2089 by 1764 pixels · CFP
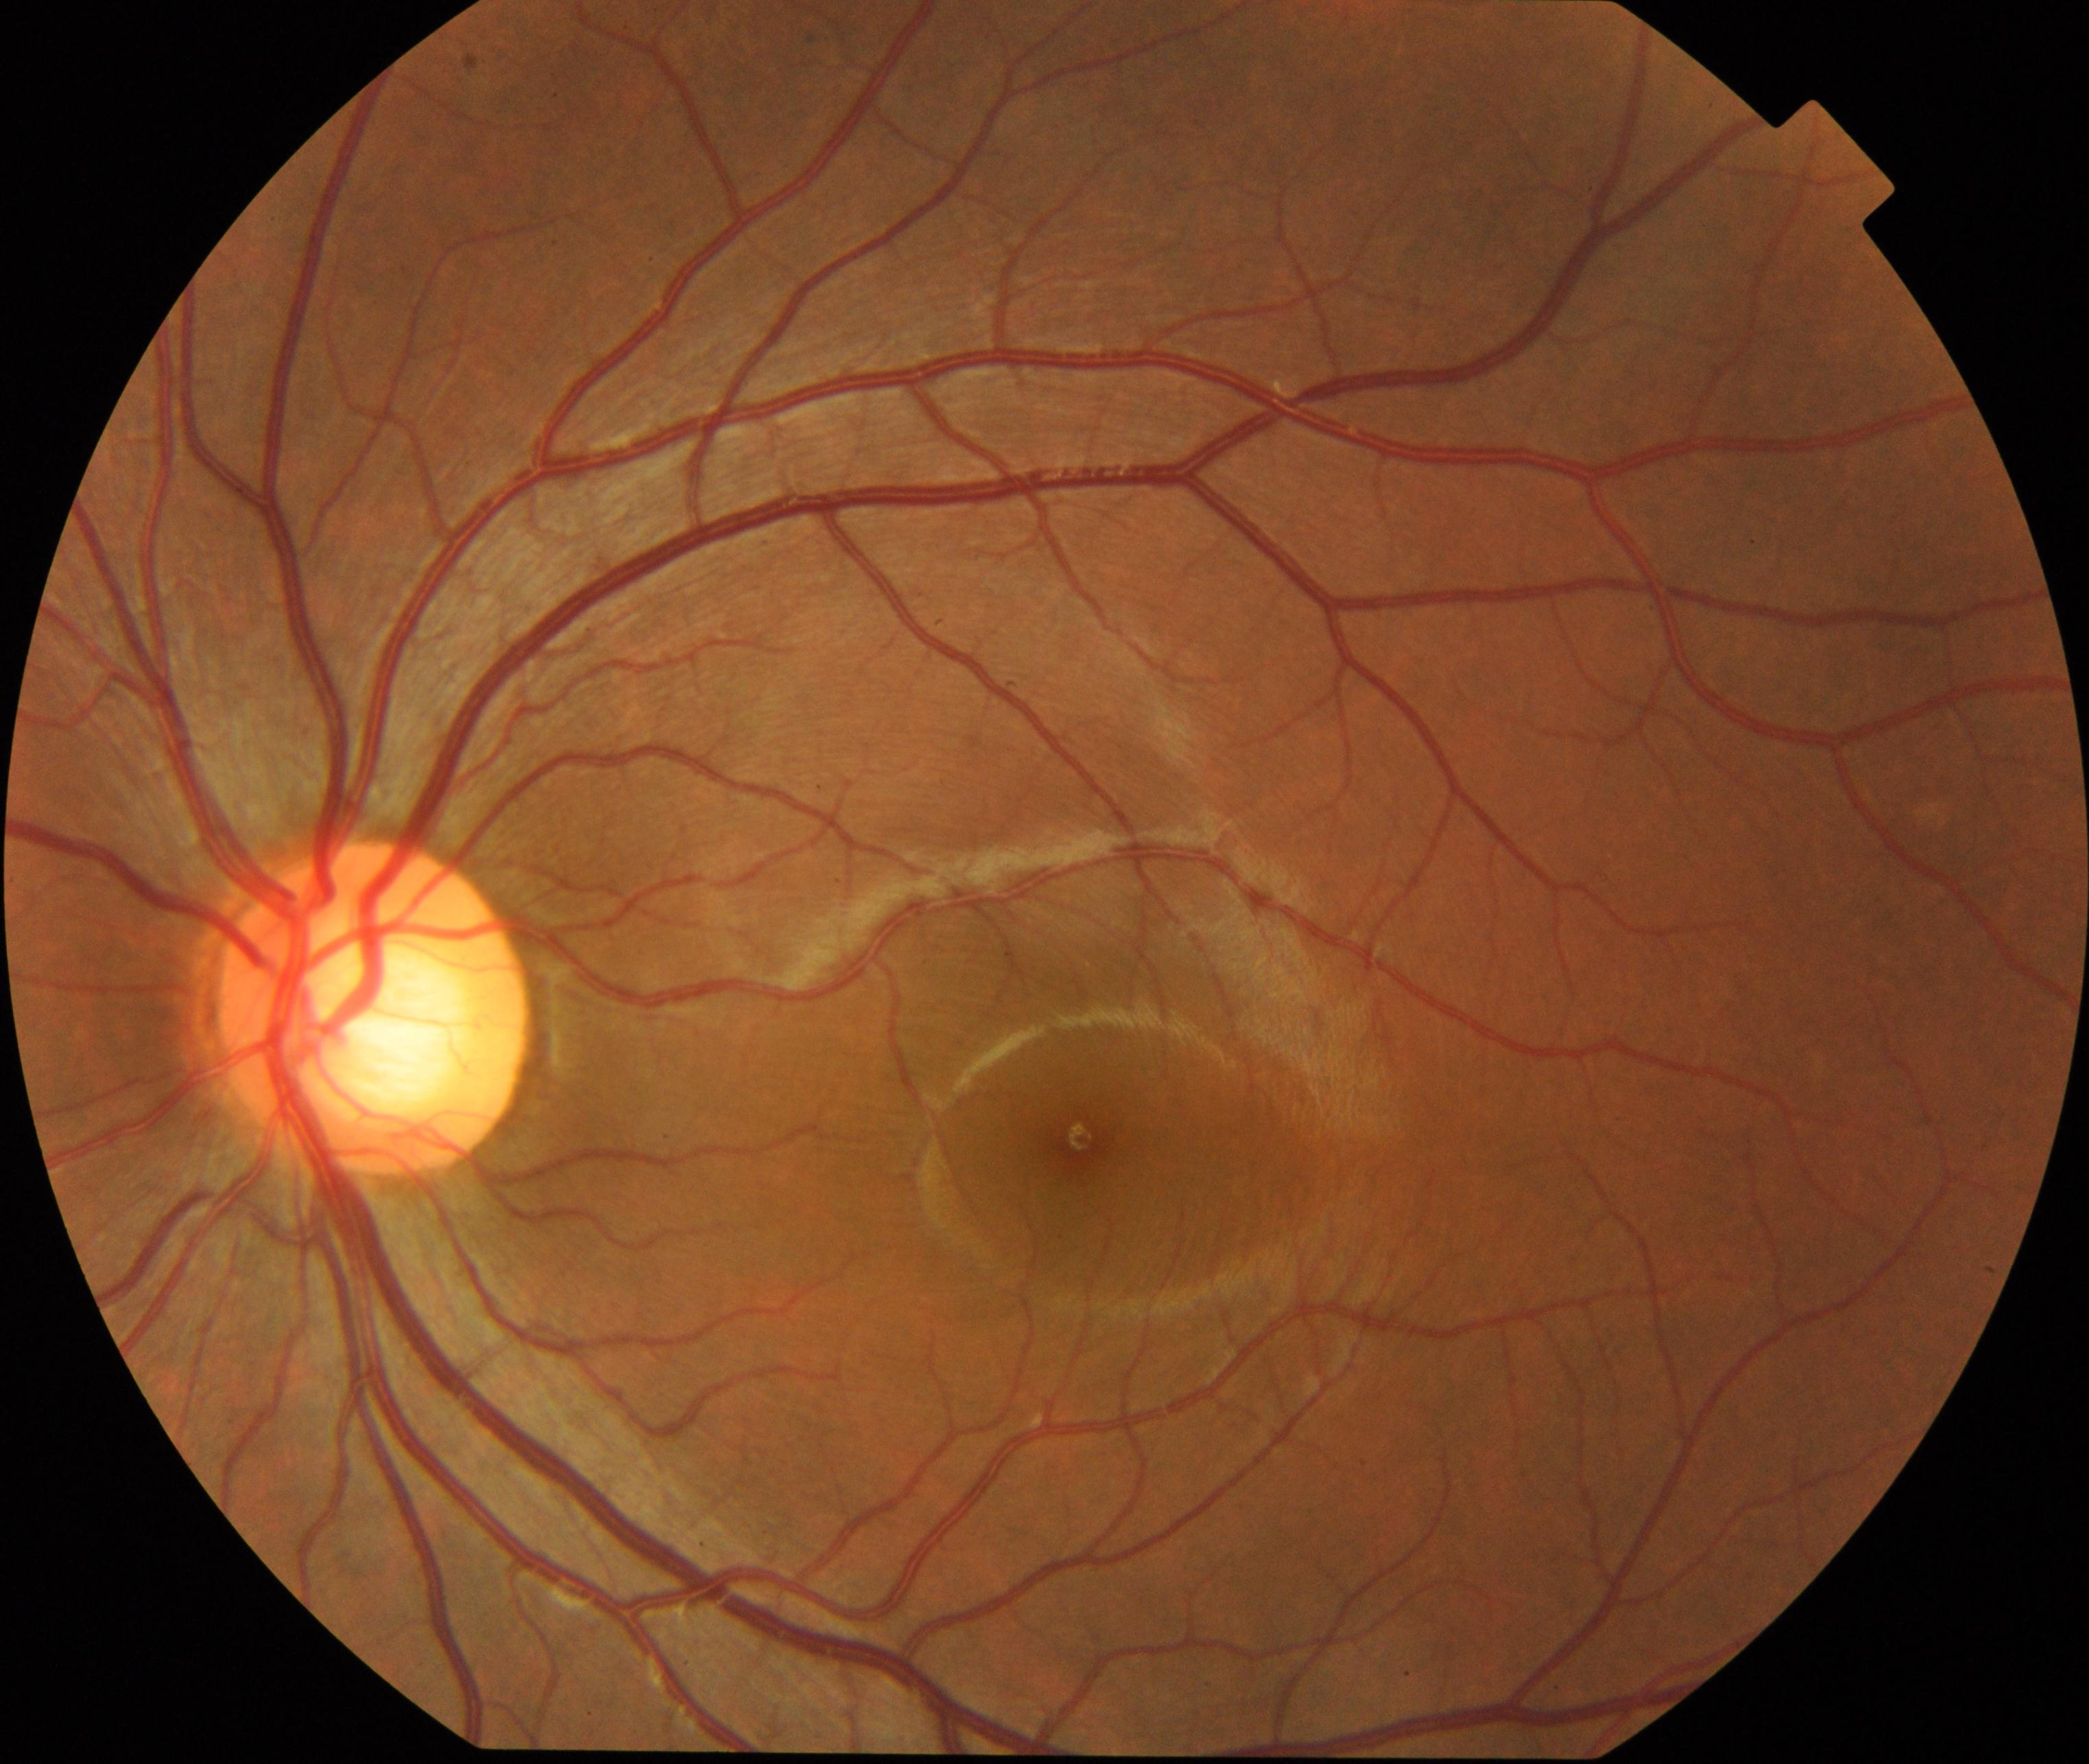

Impression: large optic cup.